640x480; wide-field fundus photograph of an infant; 130° field of view (Clarity RetCam 3).
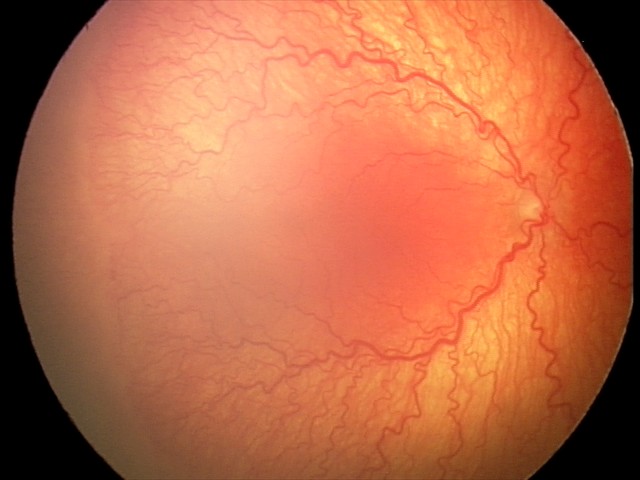
From an examination with diagnosis of A-ROP (aggressive ROP).